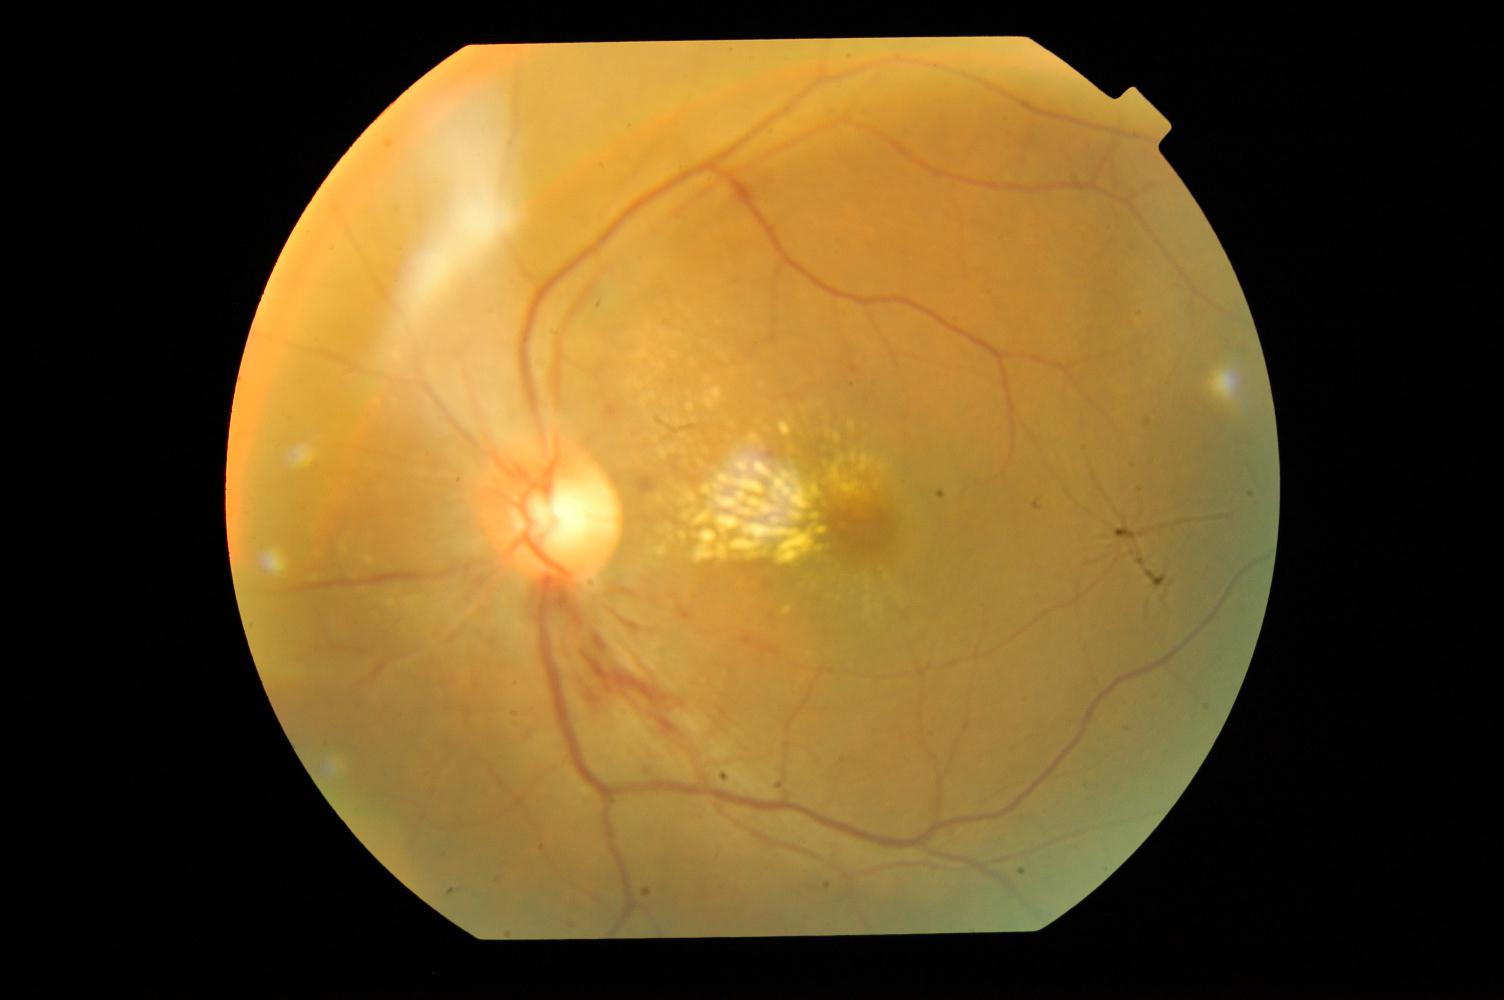
Color fundus photograph showing hypertensive retinopathy (HTN).